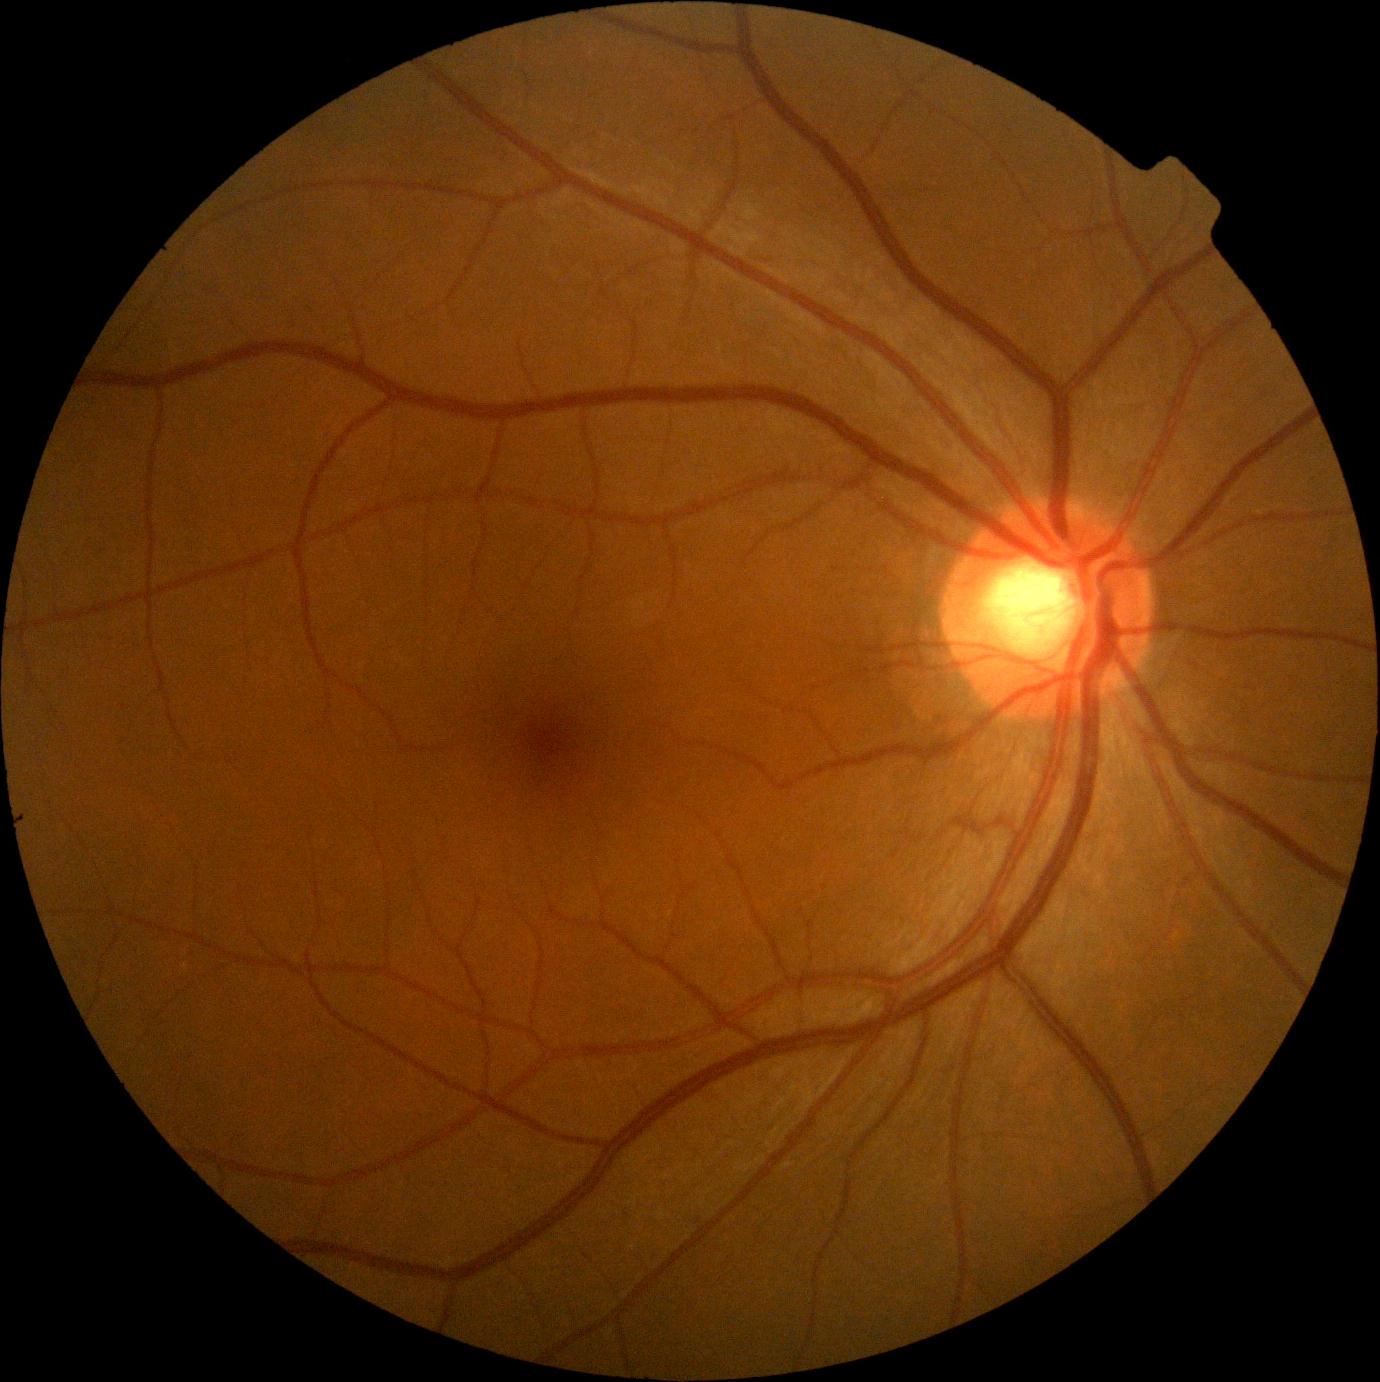

Diabetic retinopathy severity is no apparent retinopathy (grade 0).